Color fundus image.
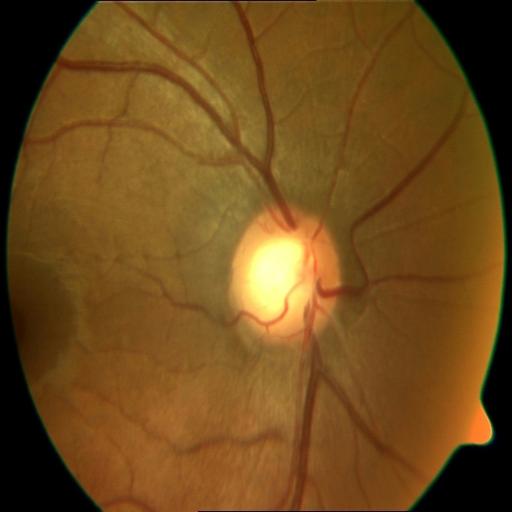

Demonstrates media haze and optic disc cupping.